2352 x 1568 pixels — 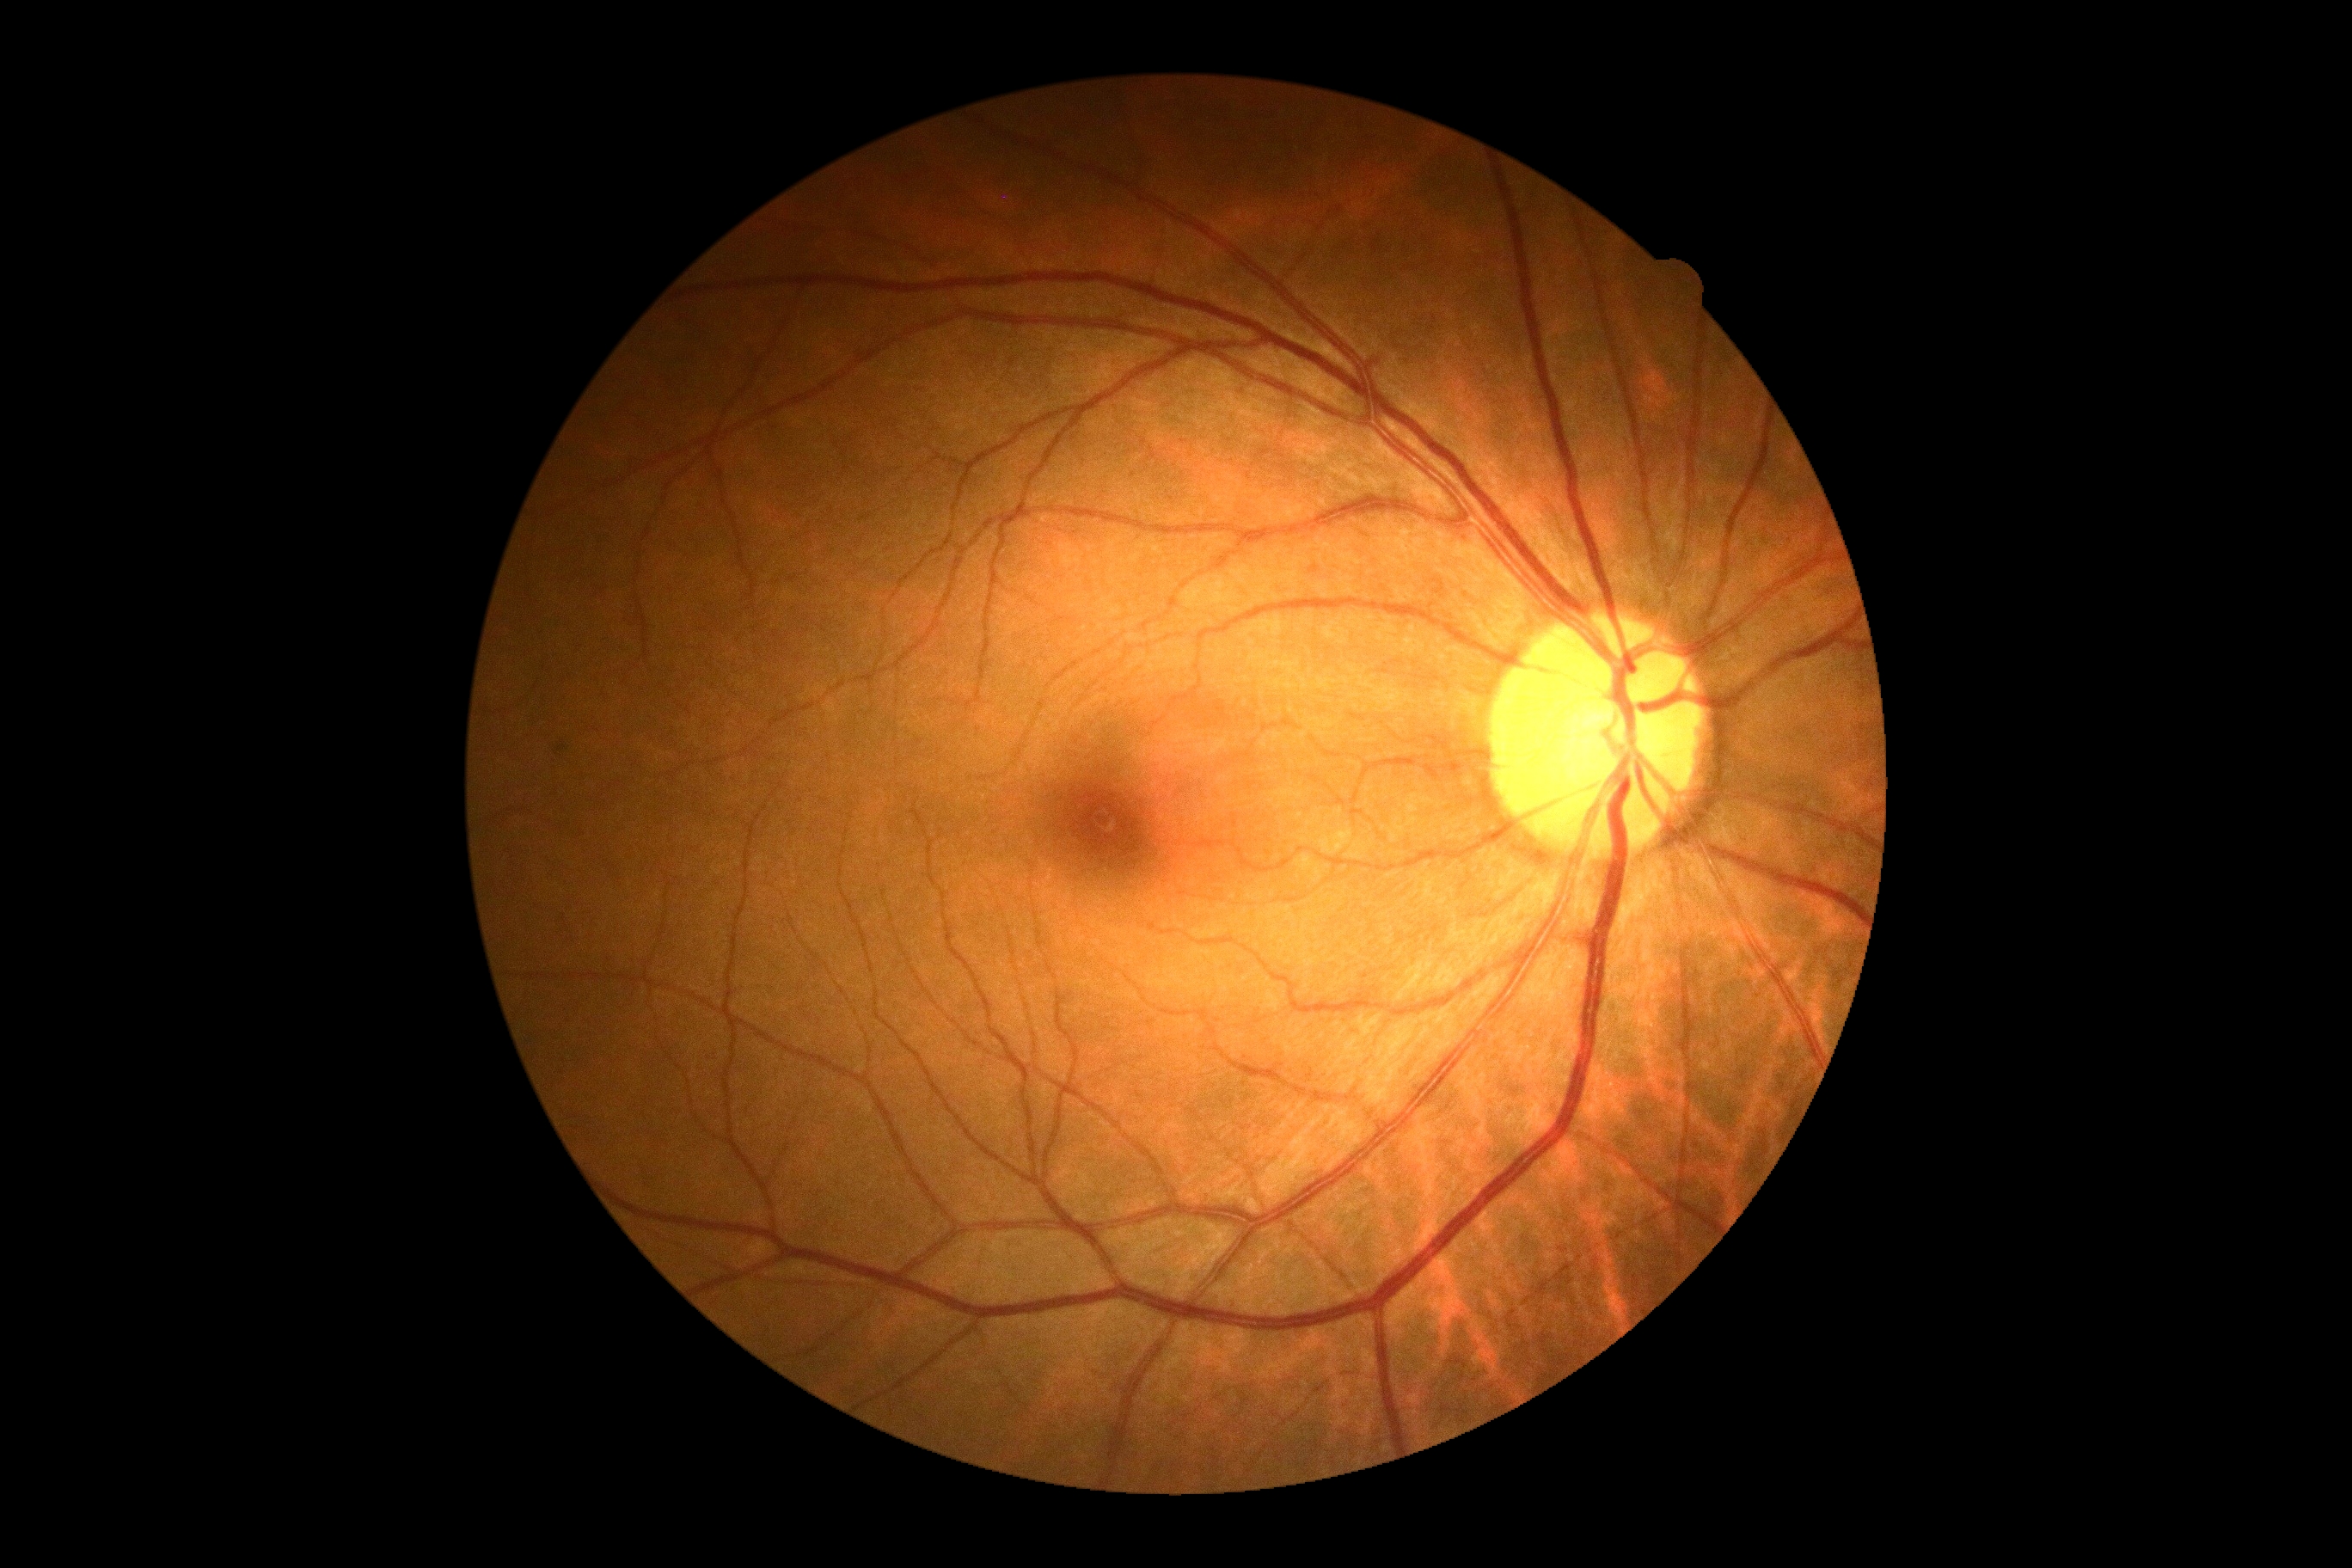
{
  "dr_grade": "grade 0 (no apparent retinopathy)",
  "dr_impression": "no signs of DR"
}